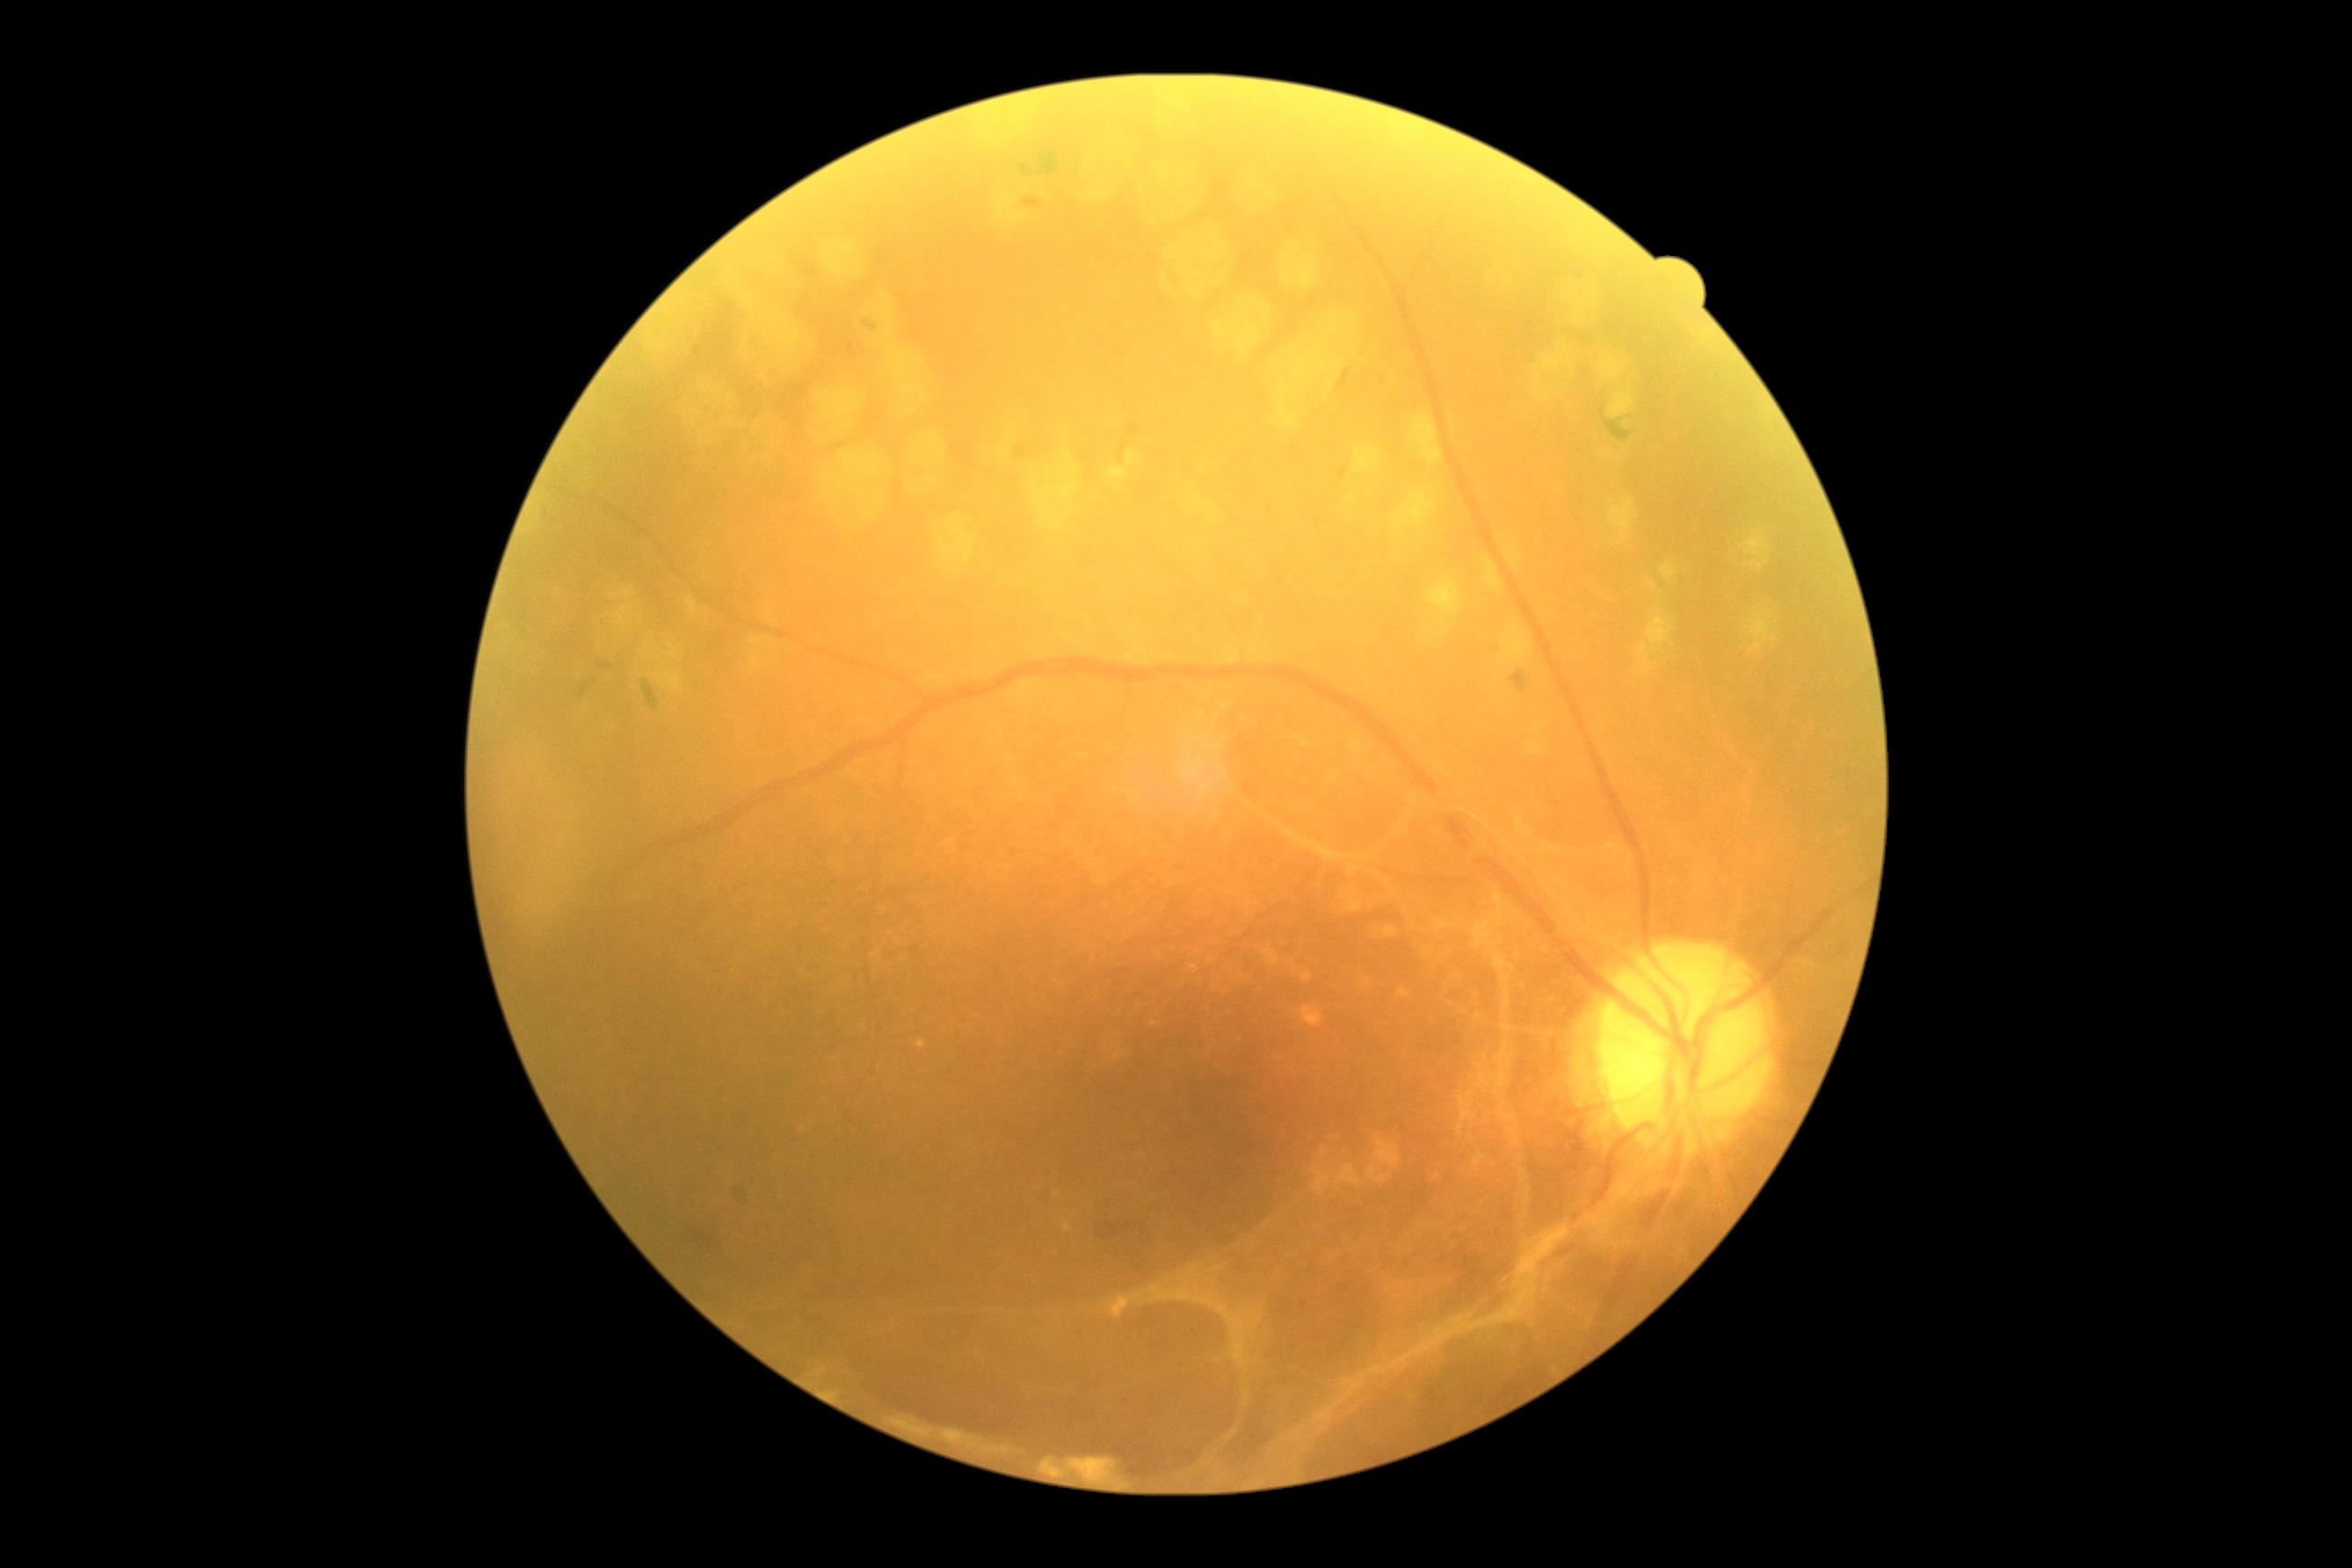

Retinopathy is 4/4.